Portable fundus photograph — 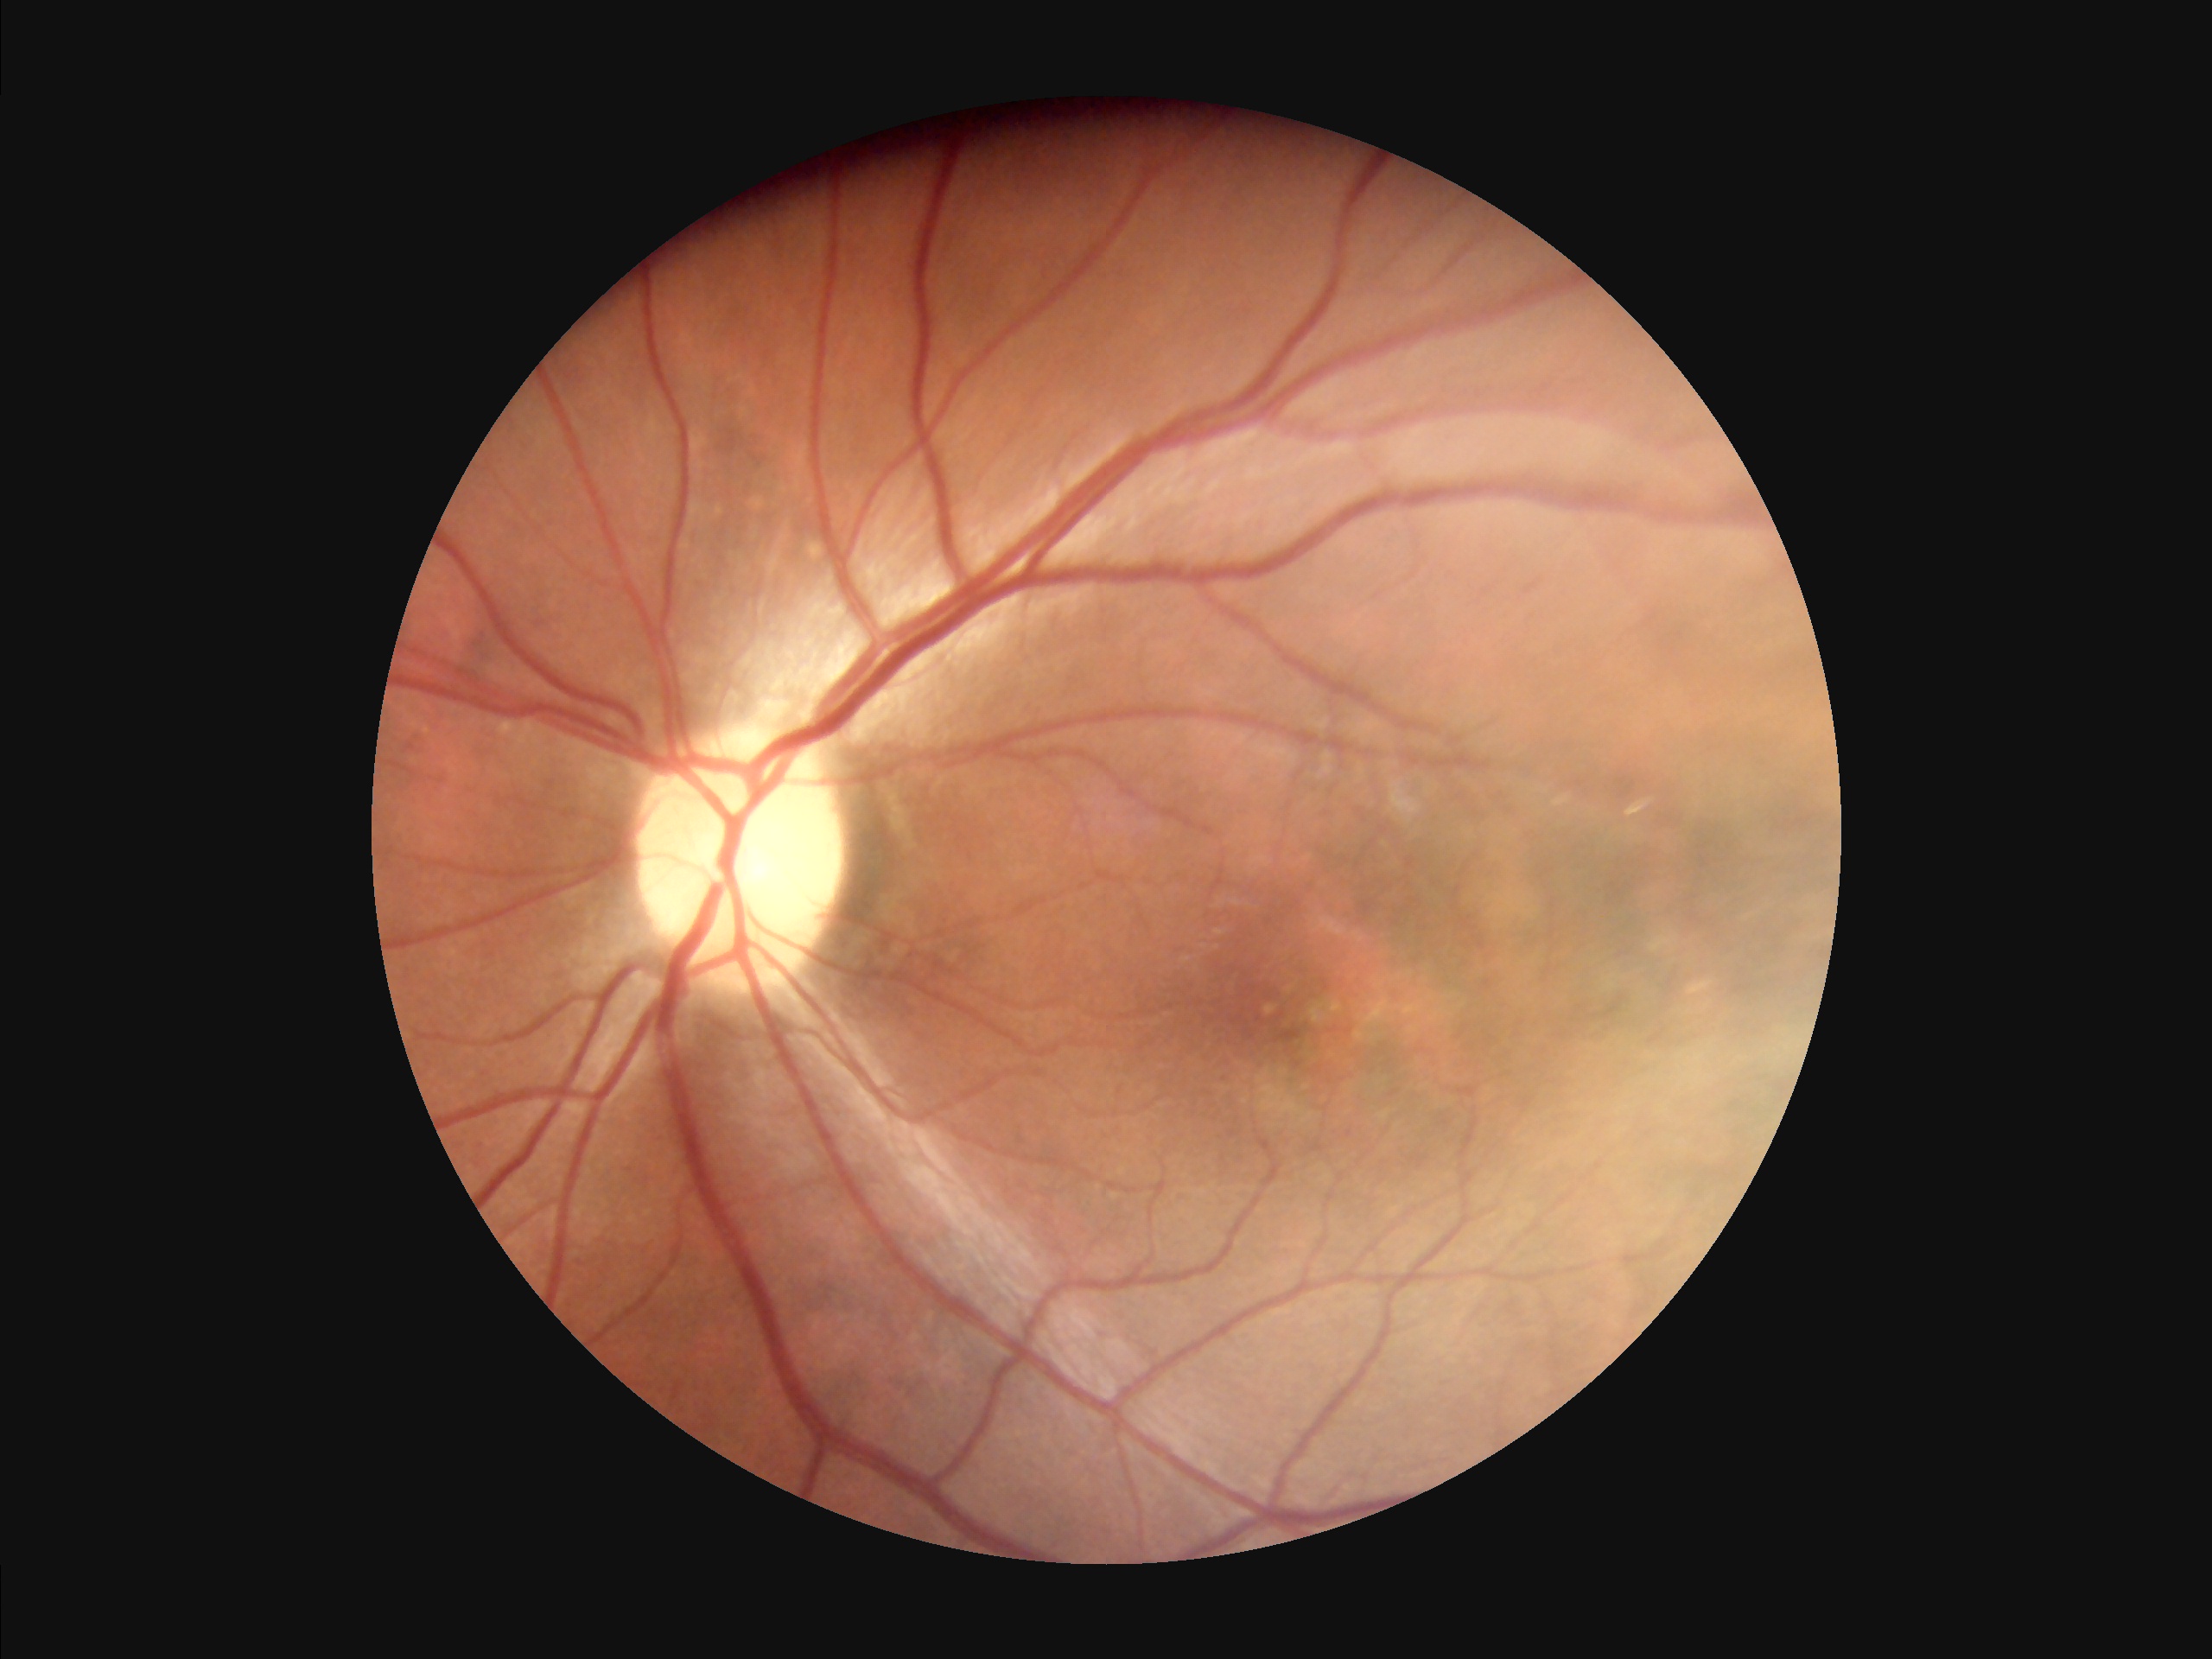
  illumination: no over- or under-exposure
  clarity: clear with no noticeable blur
  contrast: good dynamic range
  overall_quality: good and suitable for diagnostic use